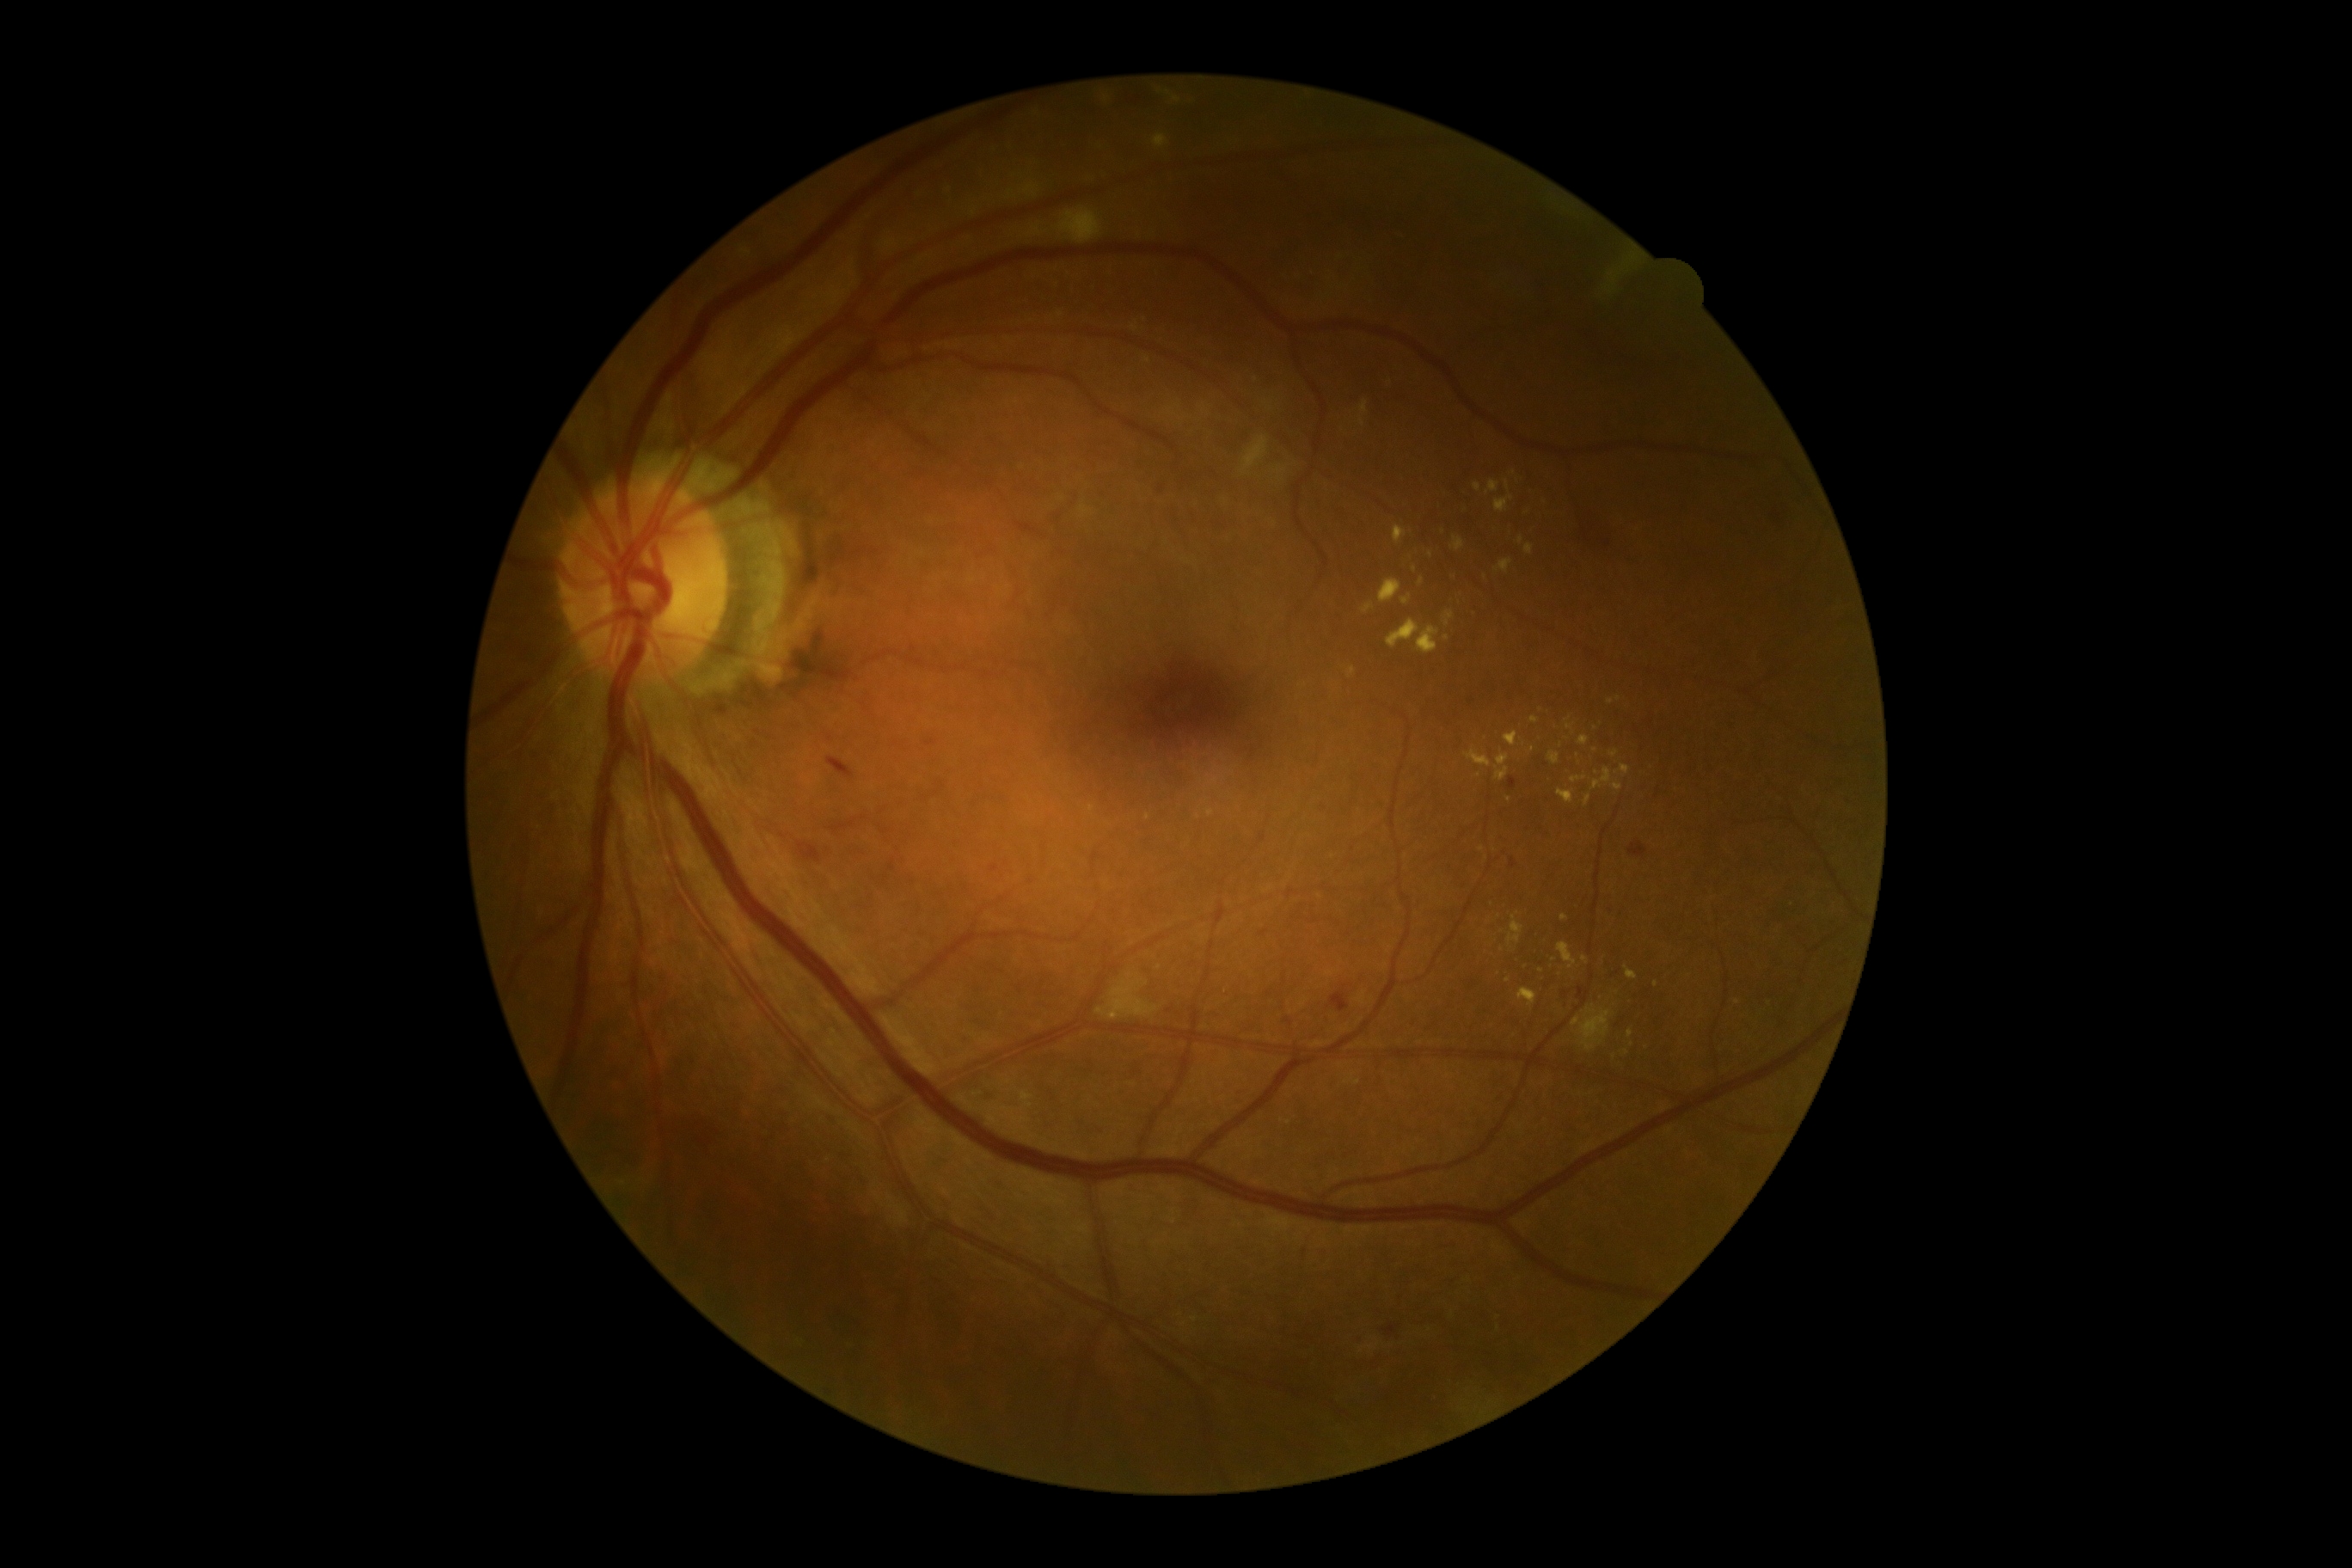
{"dr_grade": "2/4"}